240 by 240 pixels.
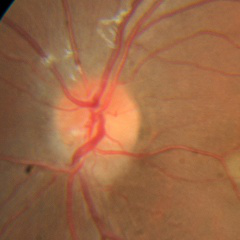
Glaucoma assessment = no glaucoma.